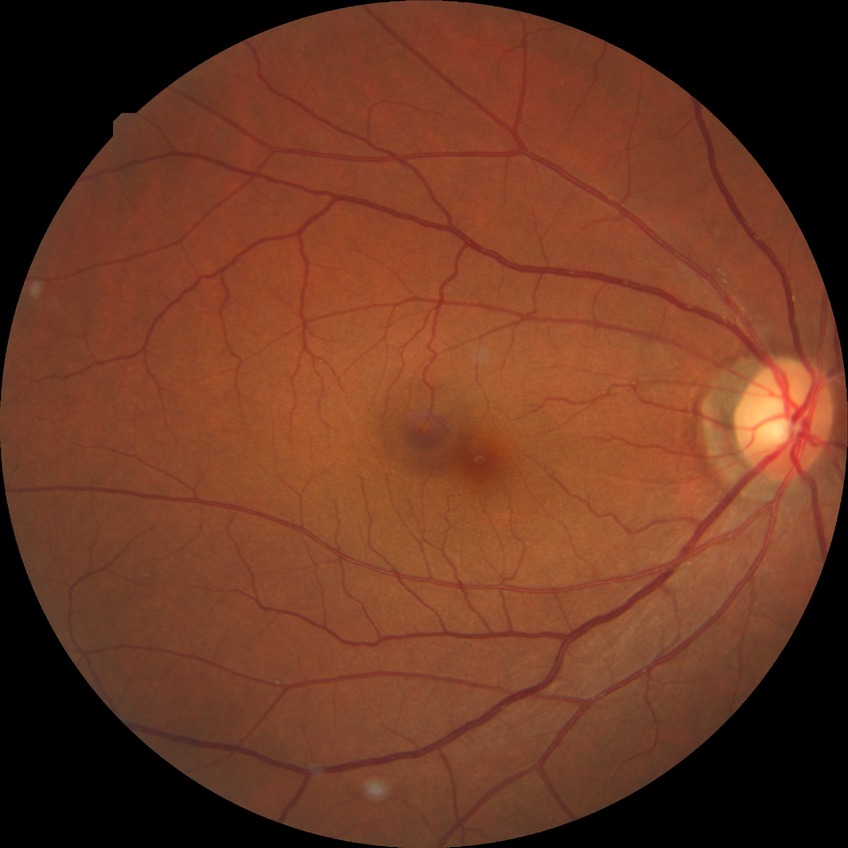
modified Davis classification: no diabetic retinopathy.